Color fundus photograph · image size 1380x1382
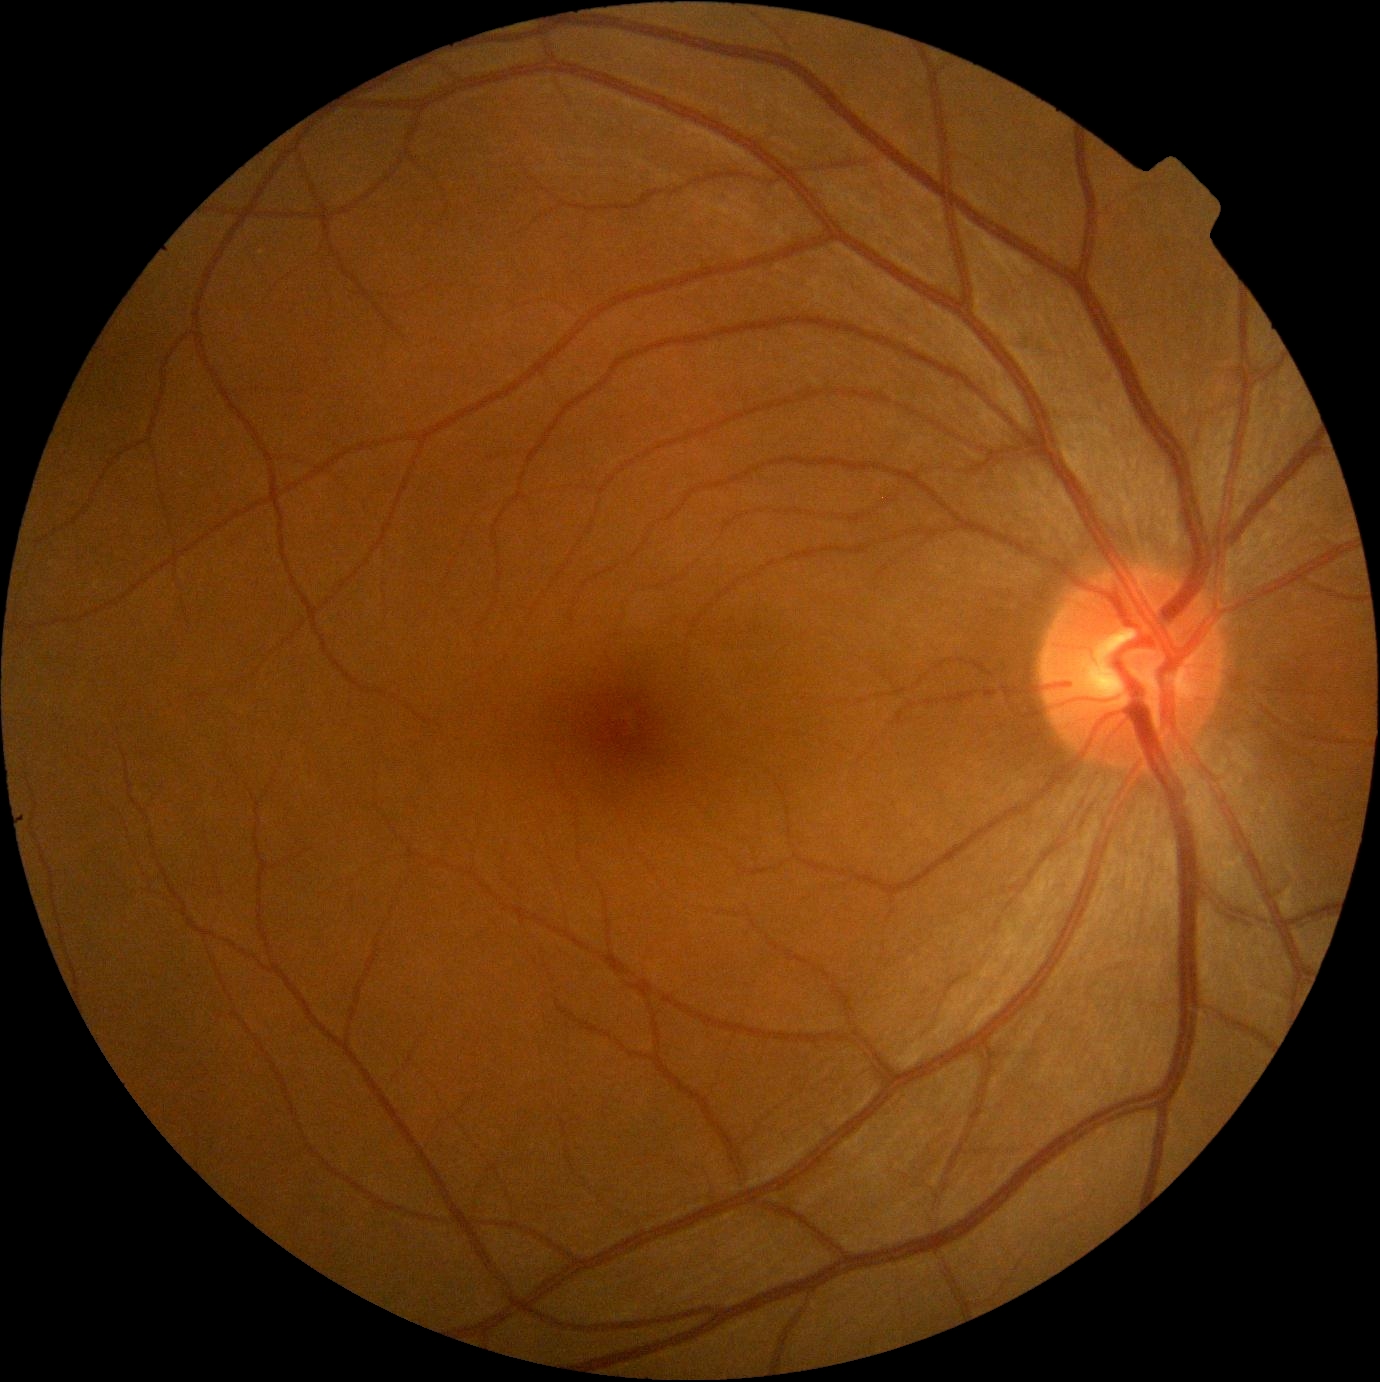

DR stage is 0/4.